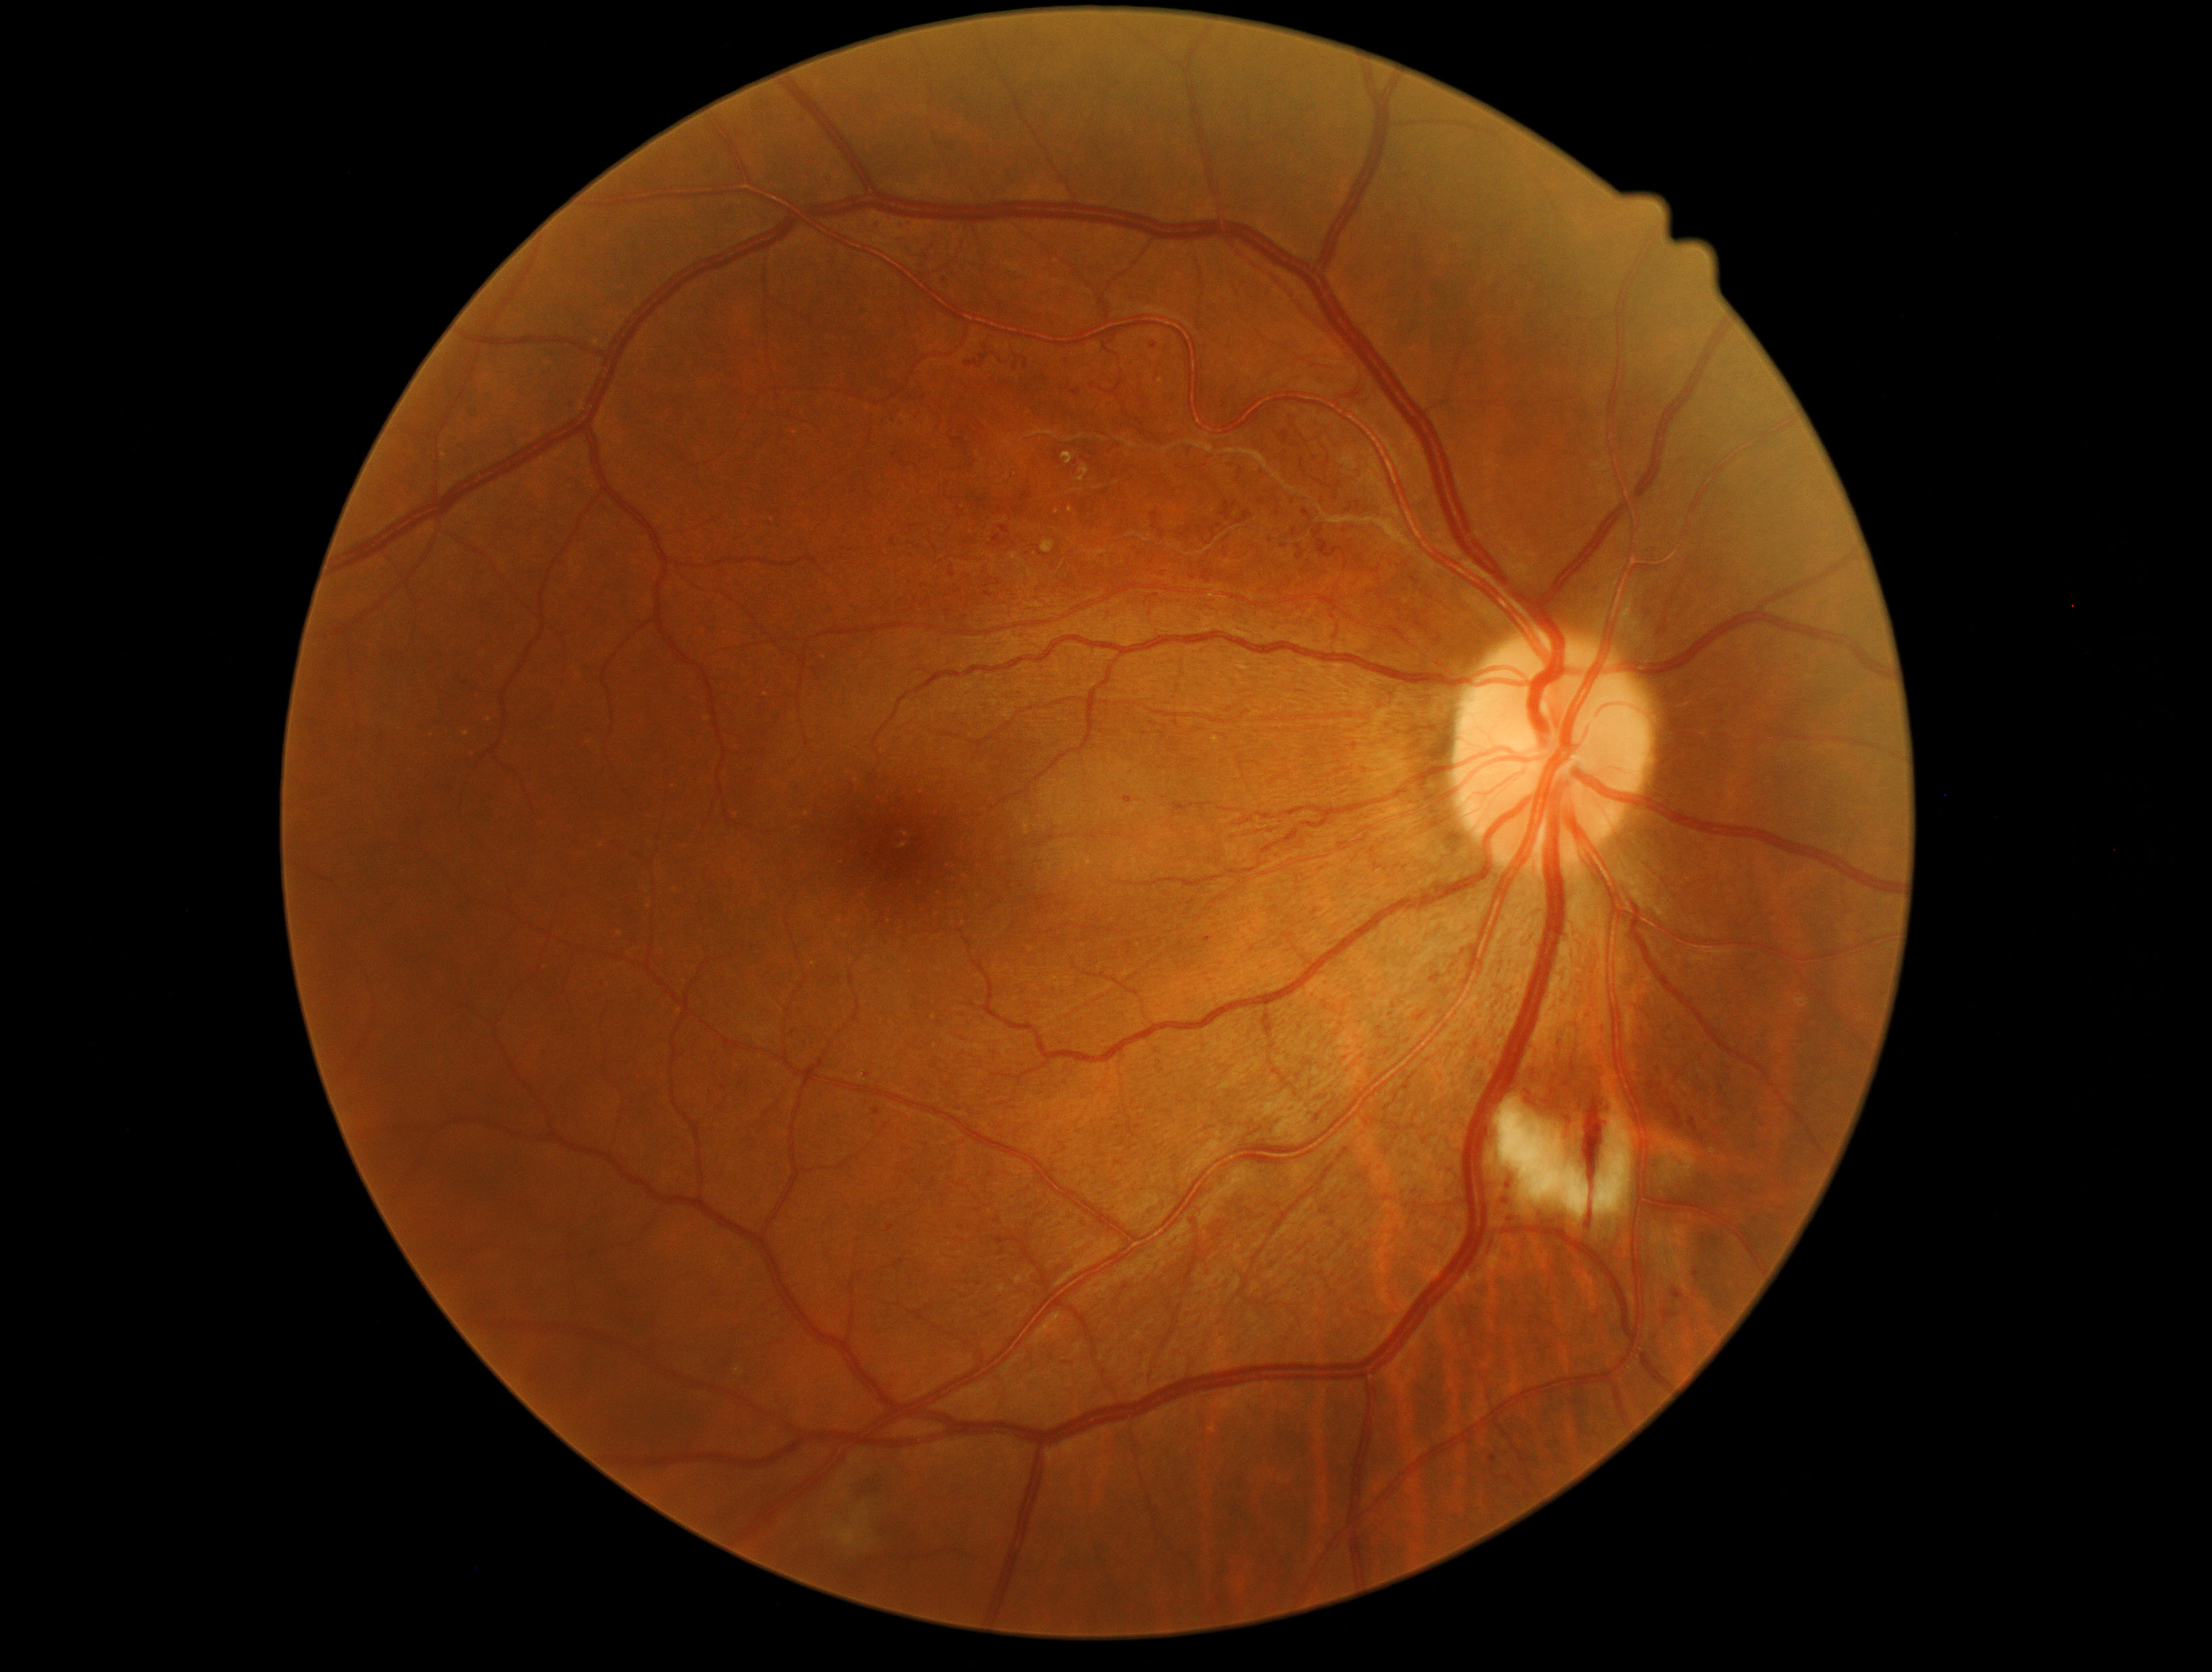
DR stage: severe non-proliferative diabetic retinopathy (grade 3).